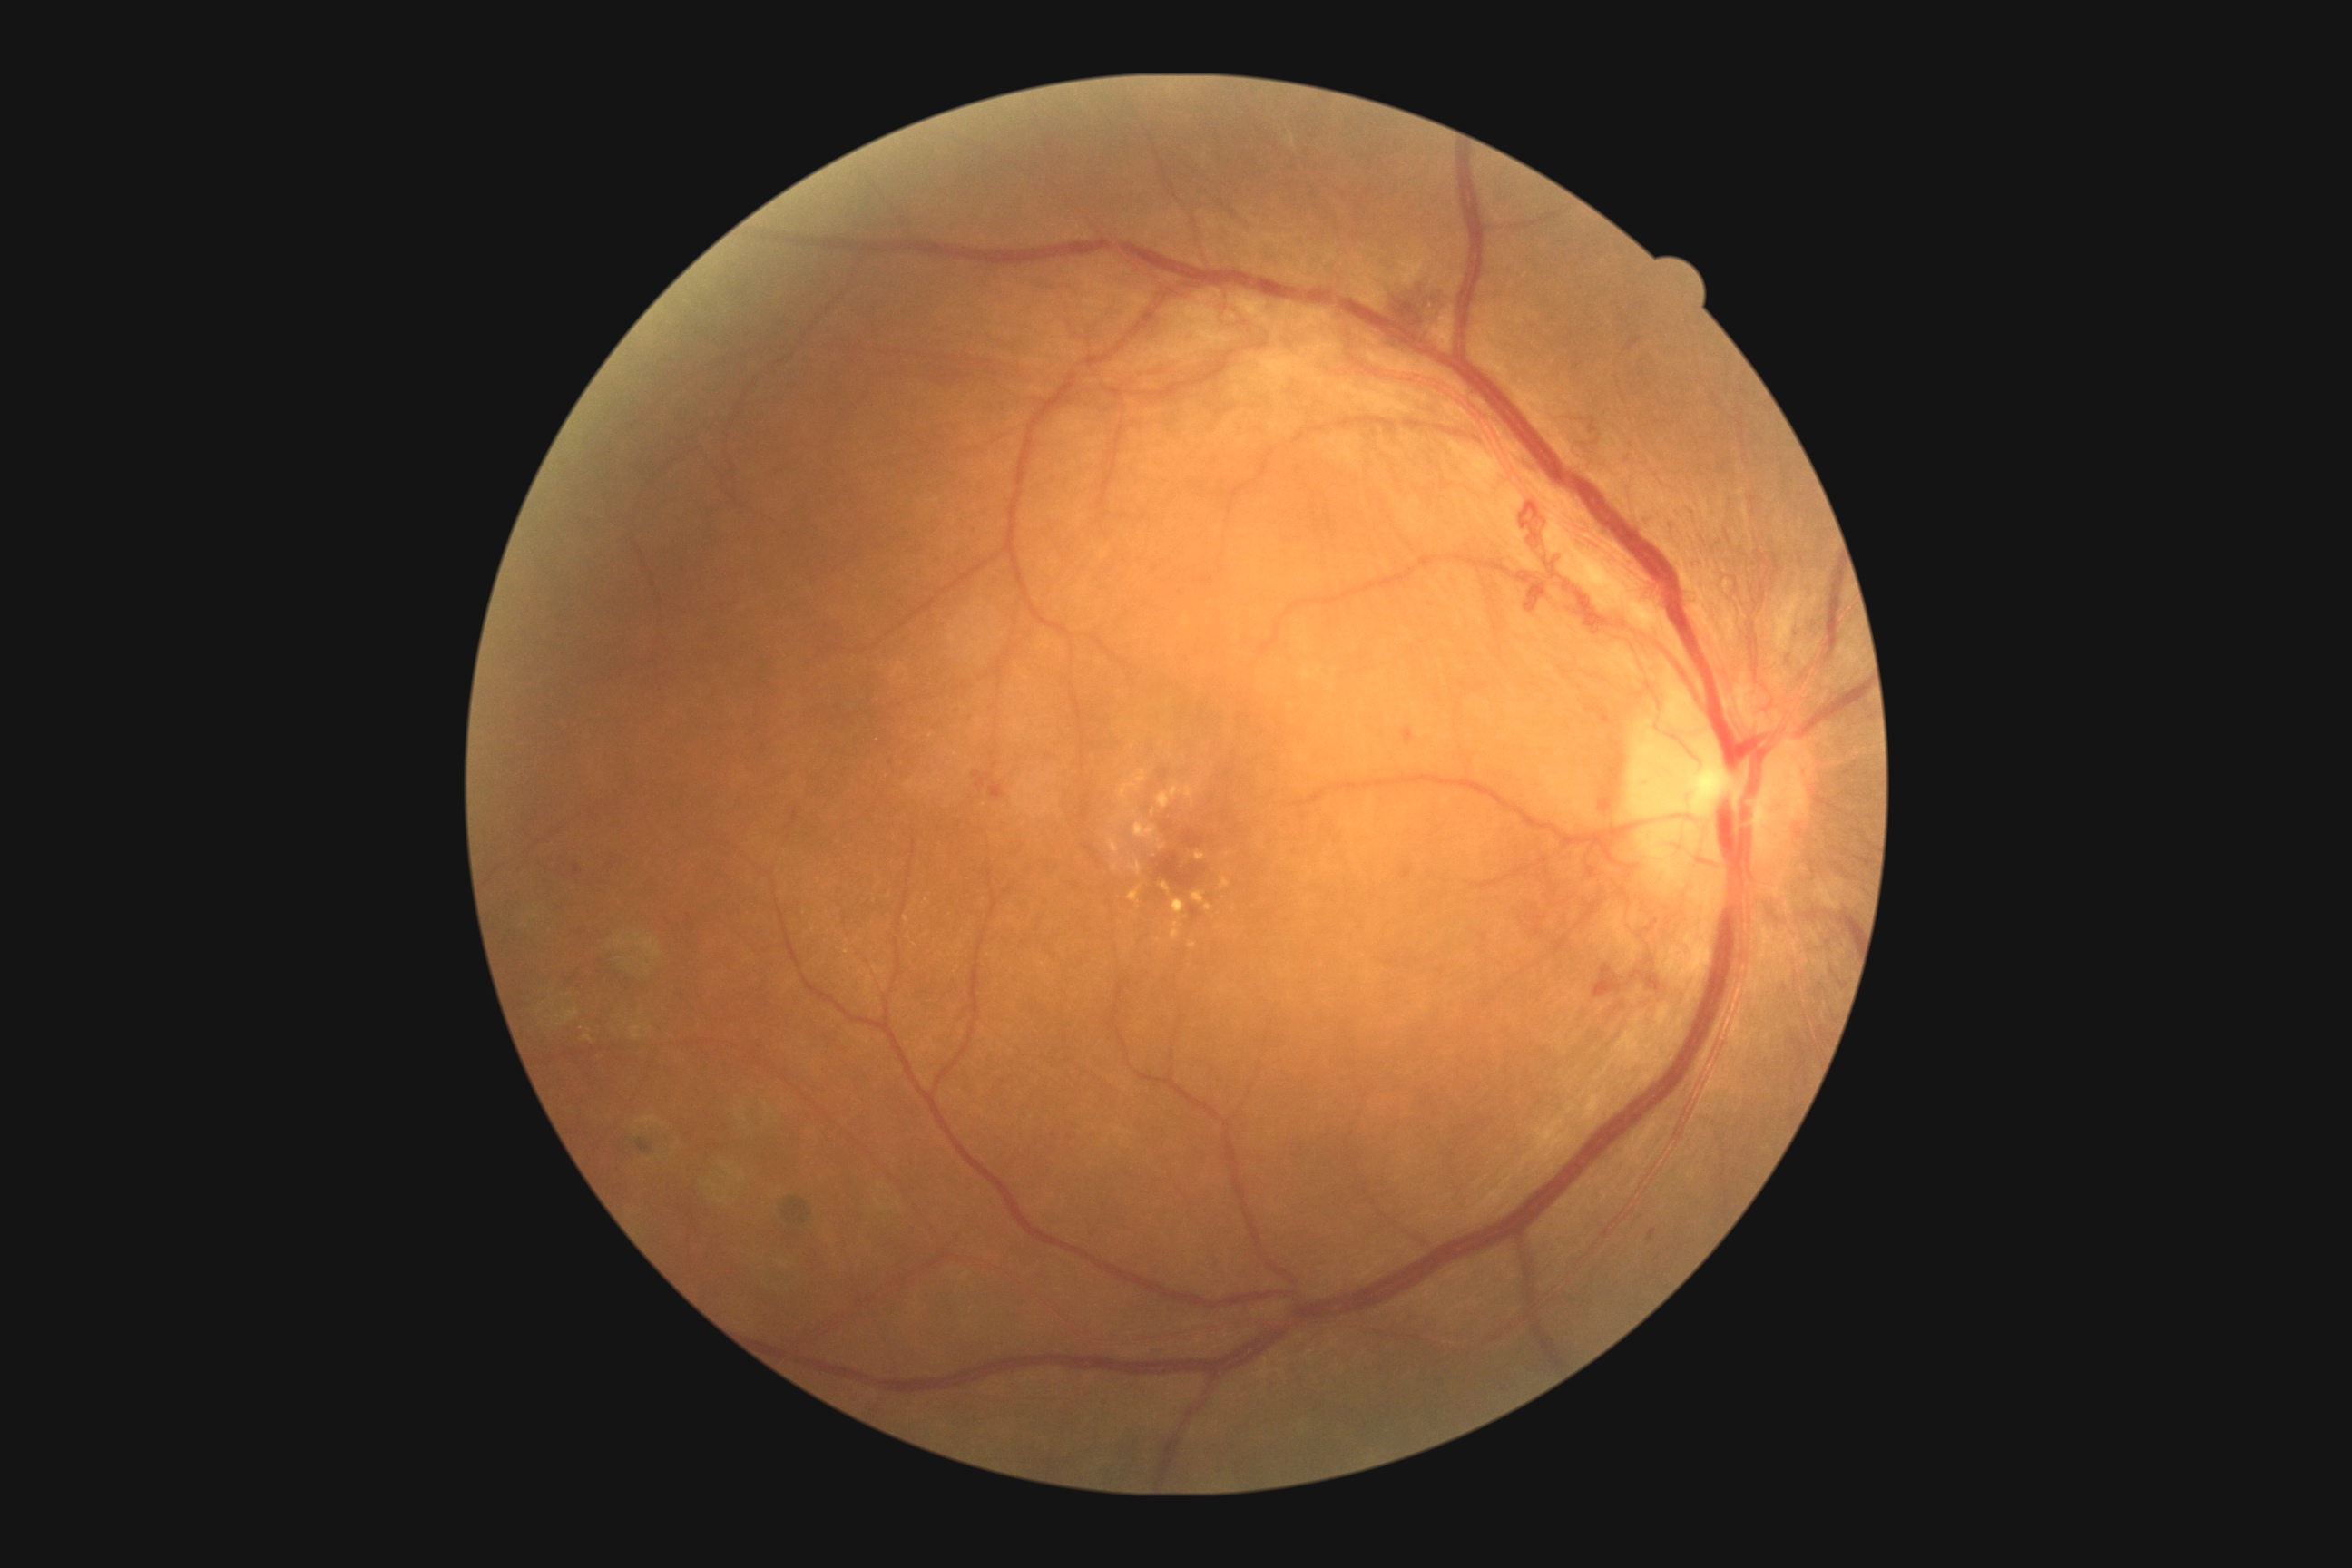 dr_grade: PDR (grade 4) — neovascularization and/or vitreous/pre-retinal hemorrhage